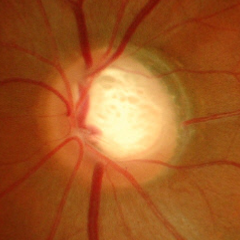

Fundus image with findings of severe glaucomatous damage. Diagnostic criteria: near-total cupping of the optic nerve head, with or without severe visual field loss within the central 10 degrees of fixation.